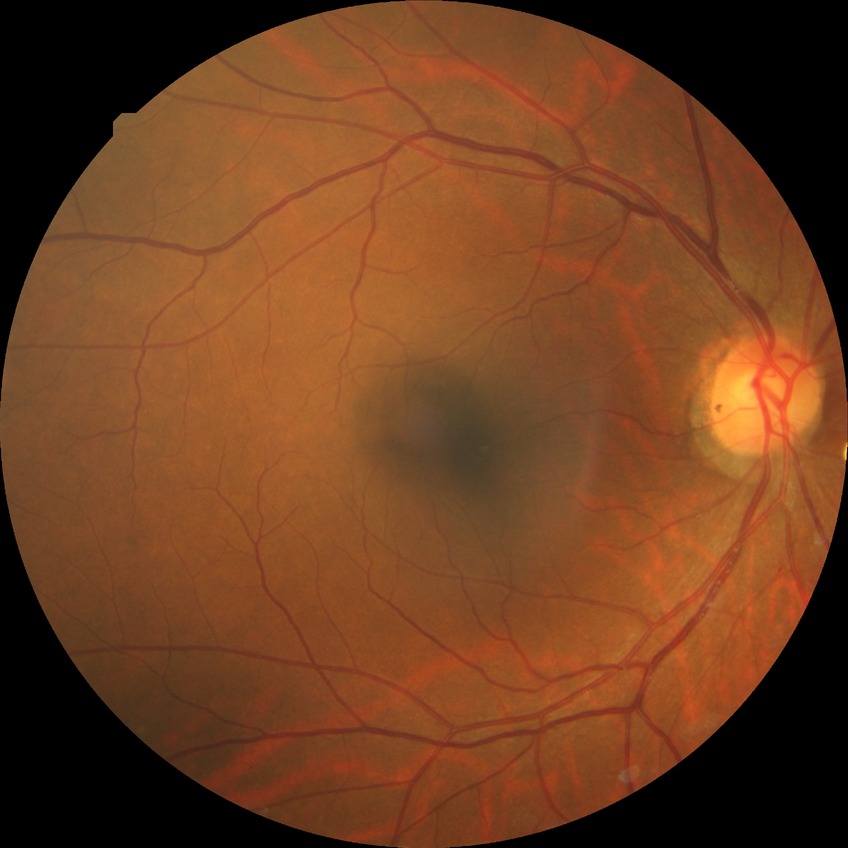

davis_grade: NDR (no diabetic retinopathy)